CFP.
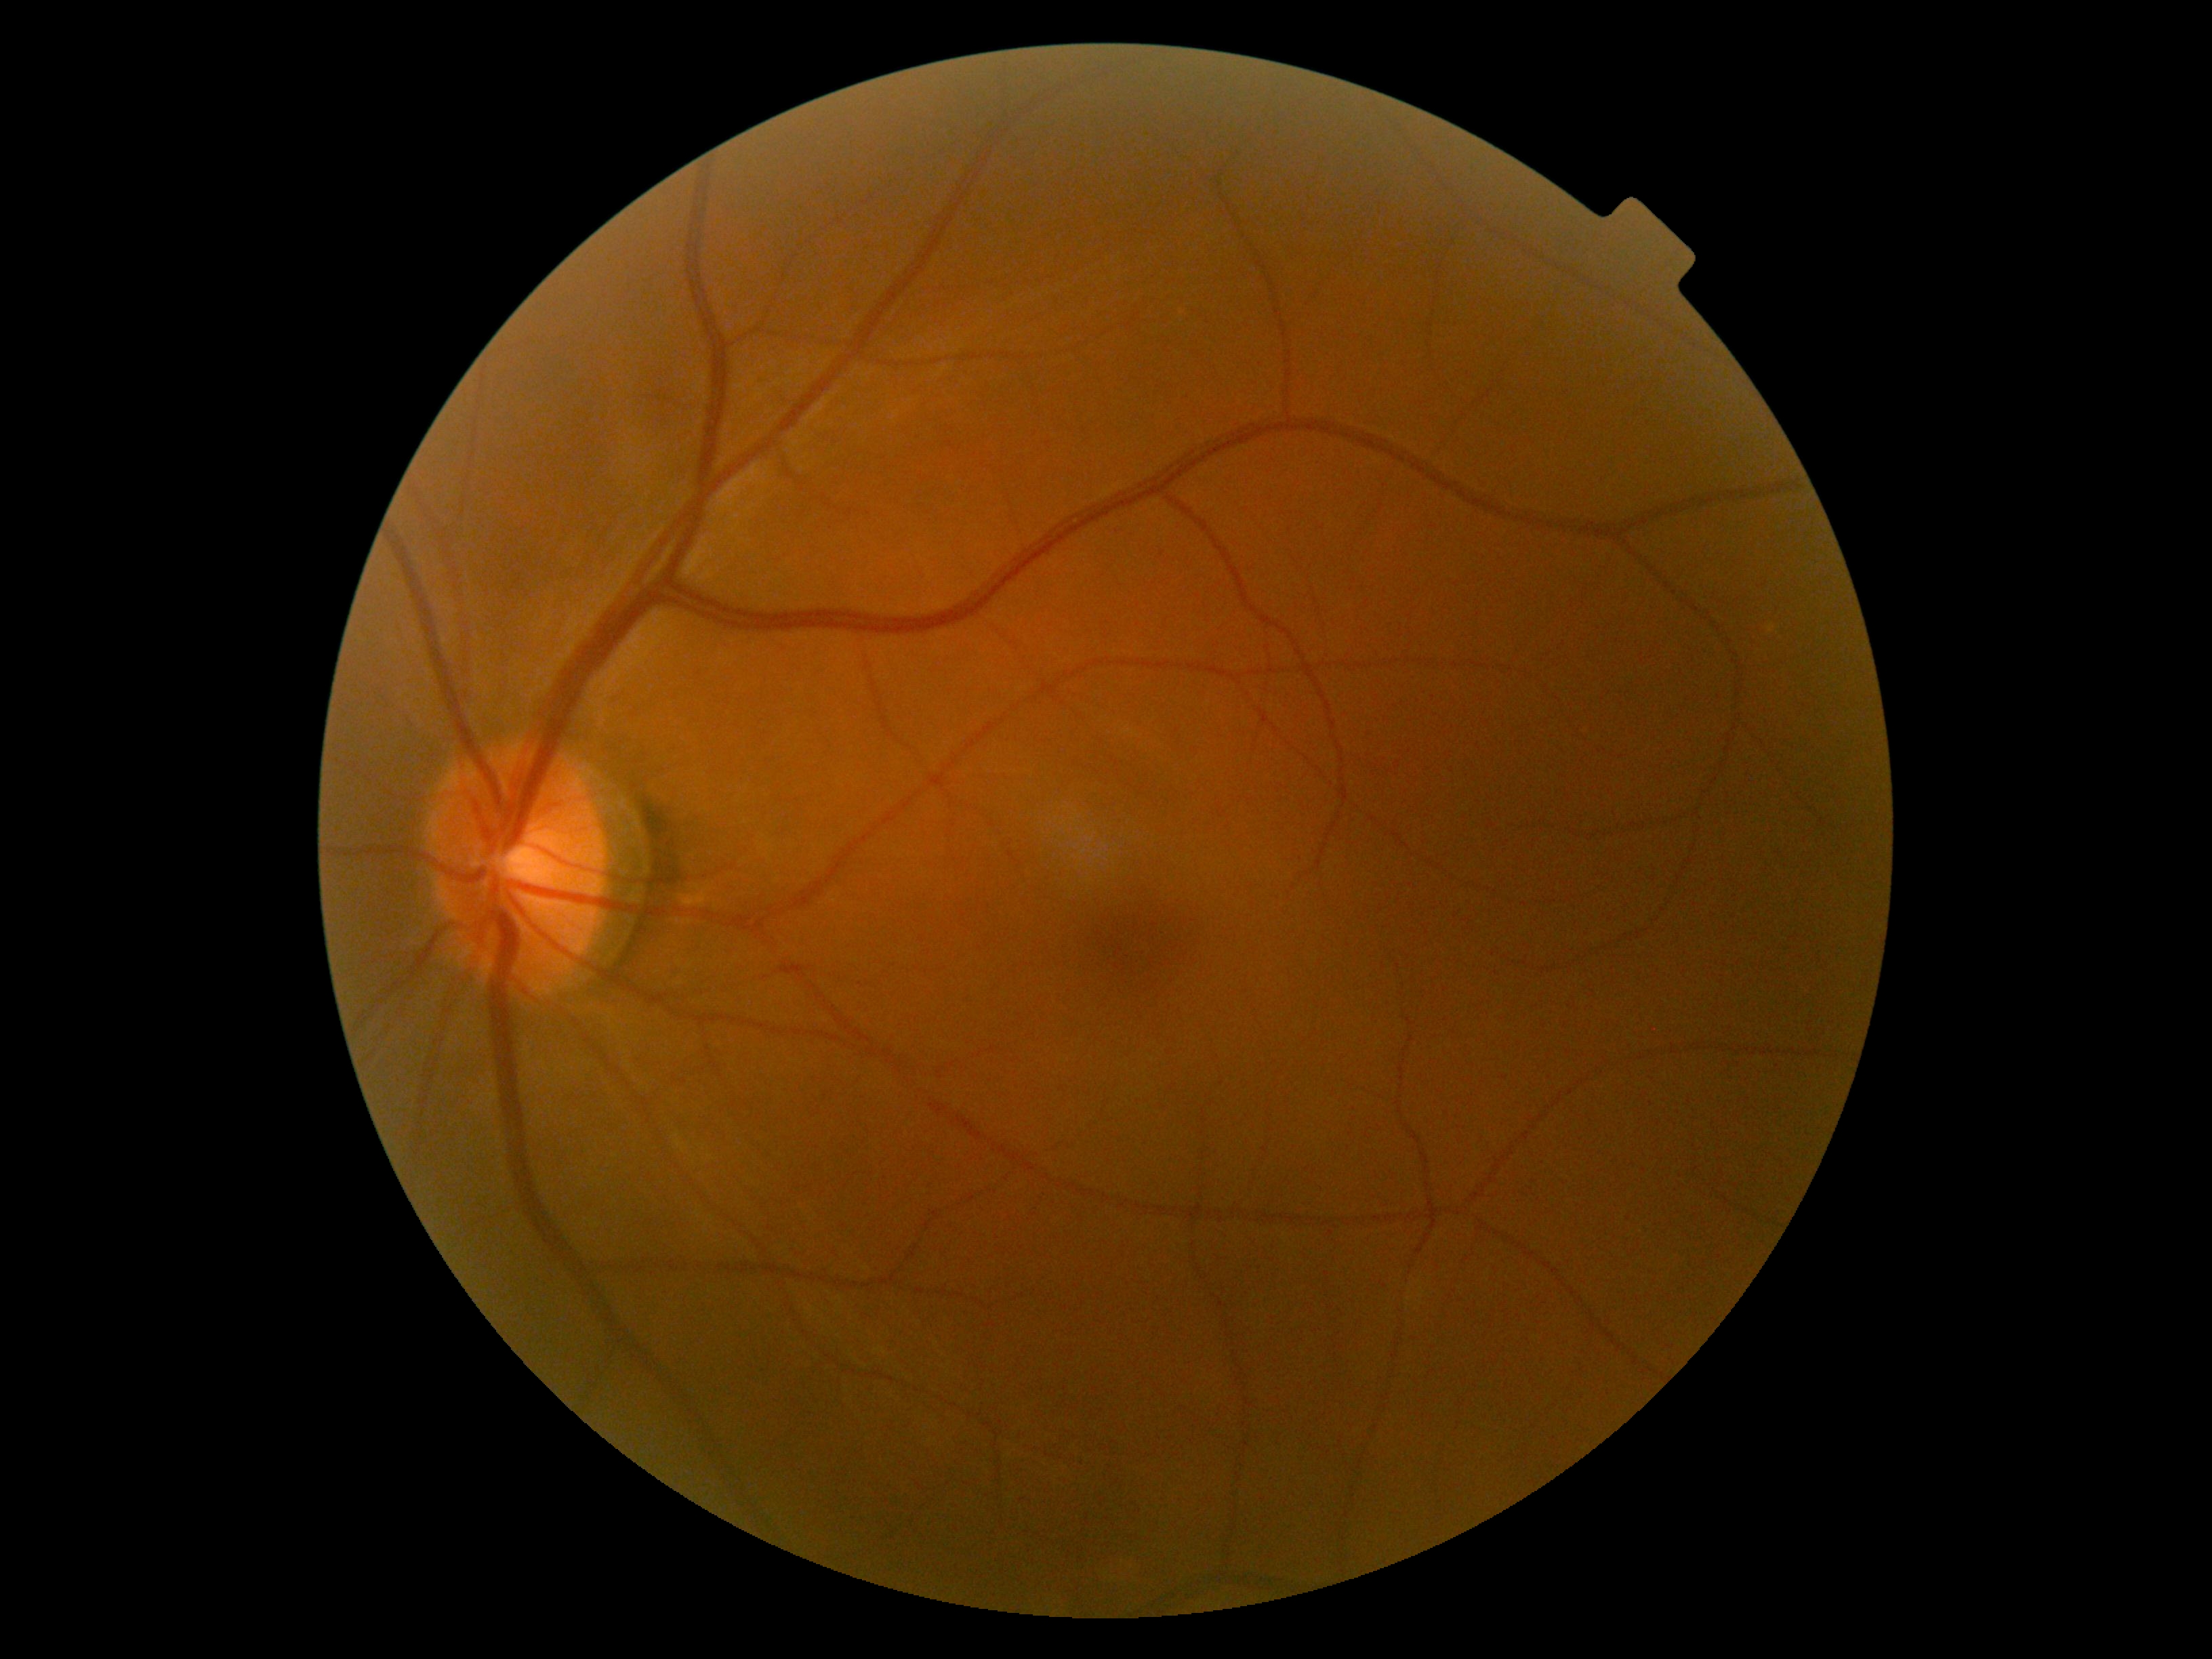

DR: grade 0 (no apparent retinopathy) — no visible signs of diabetic retinopathy.